Retinal fundus photograph
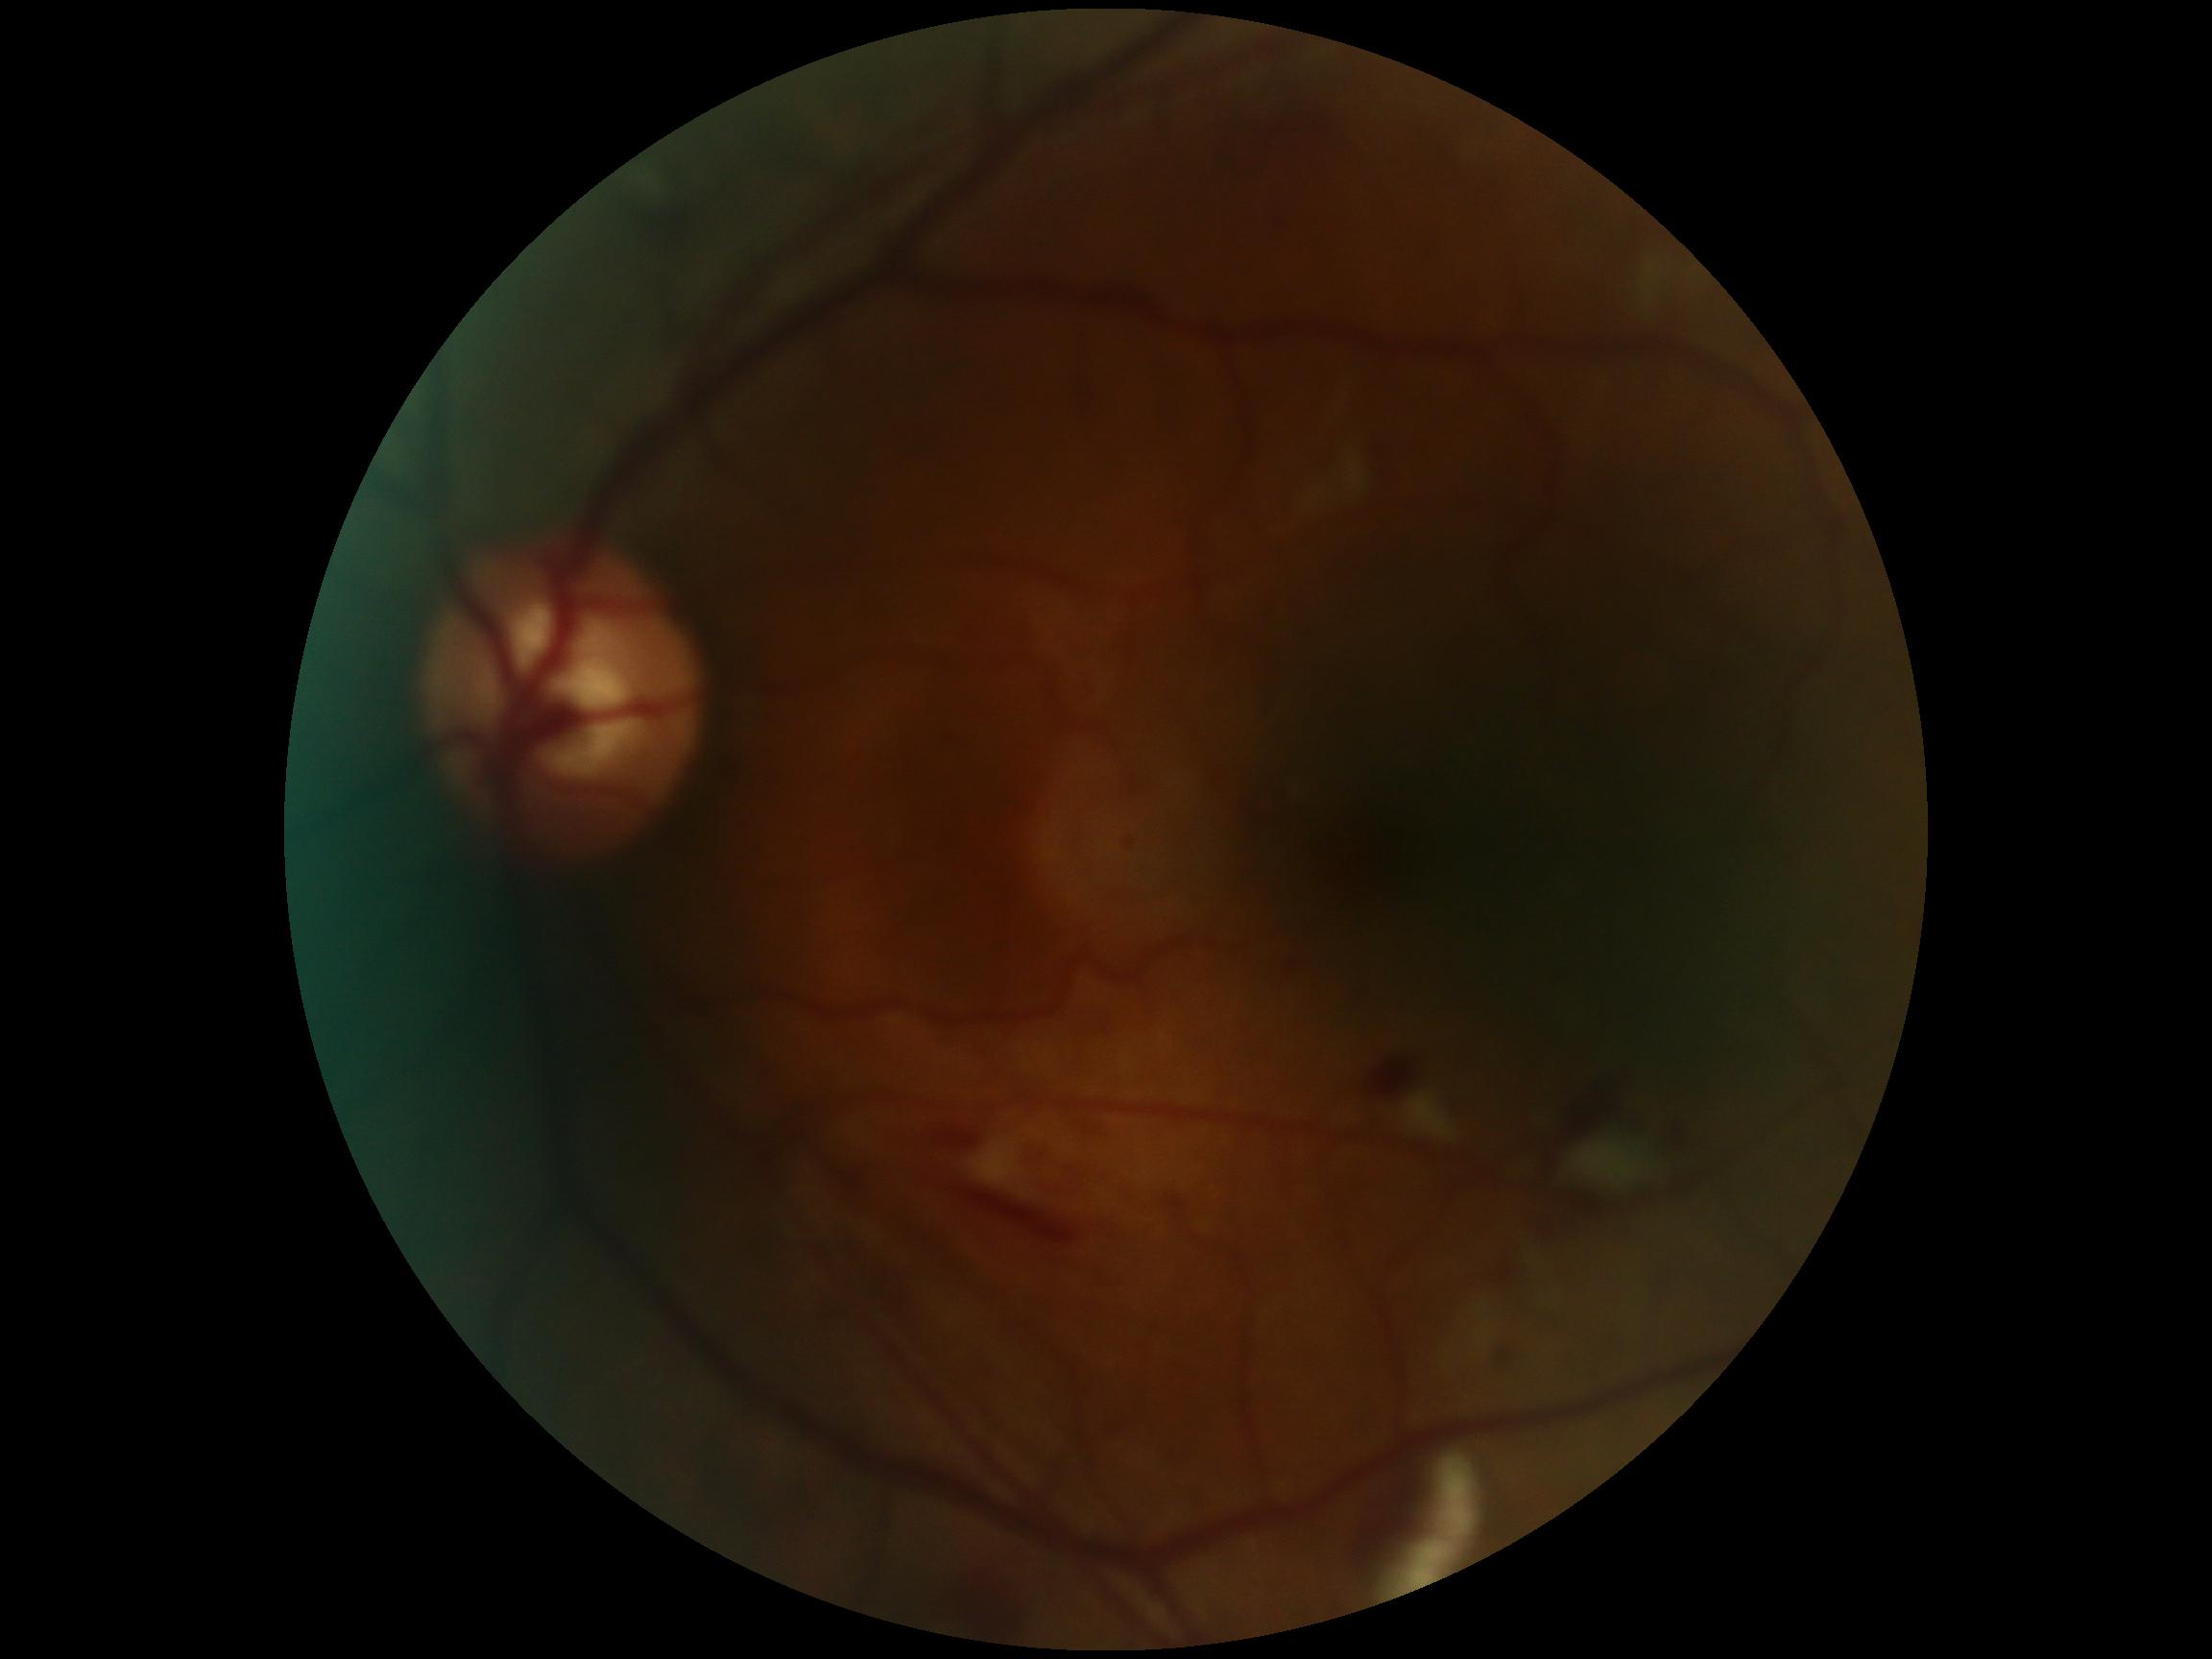
Diabetic retinopathy severity is 2.